45-degree field of view, color fundus image, 2352x1568
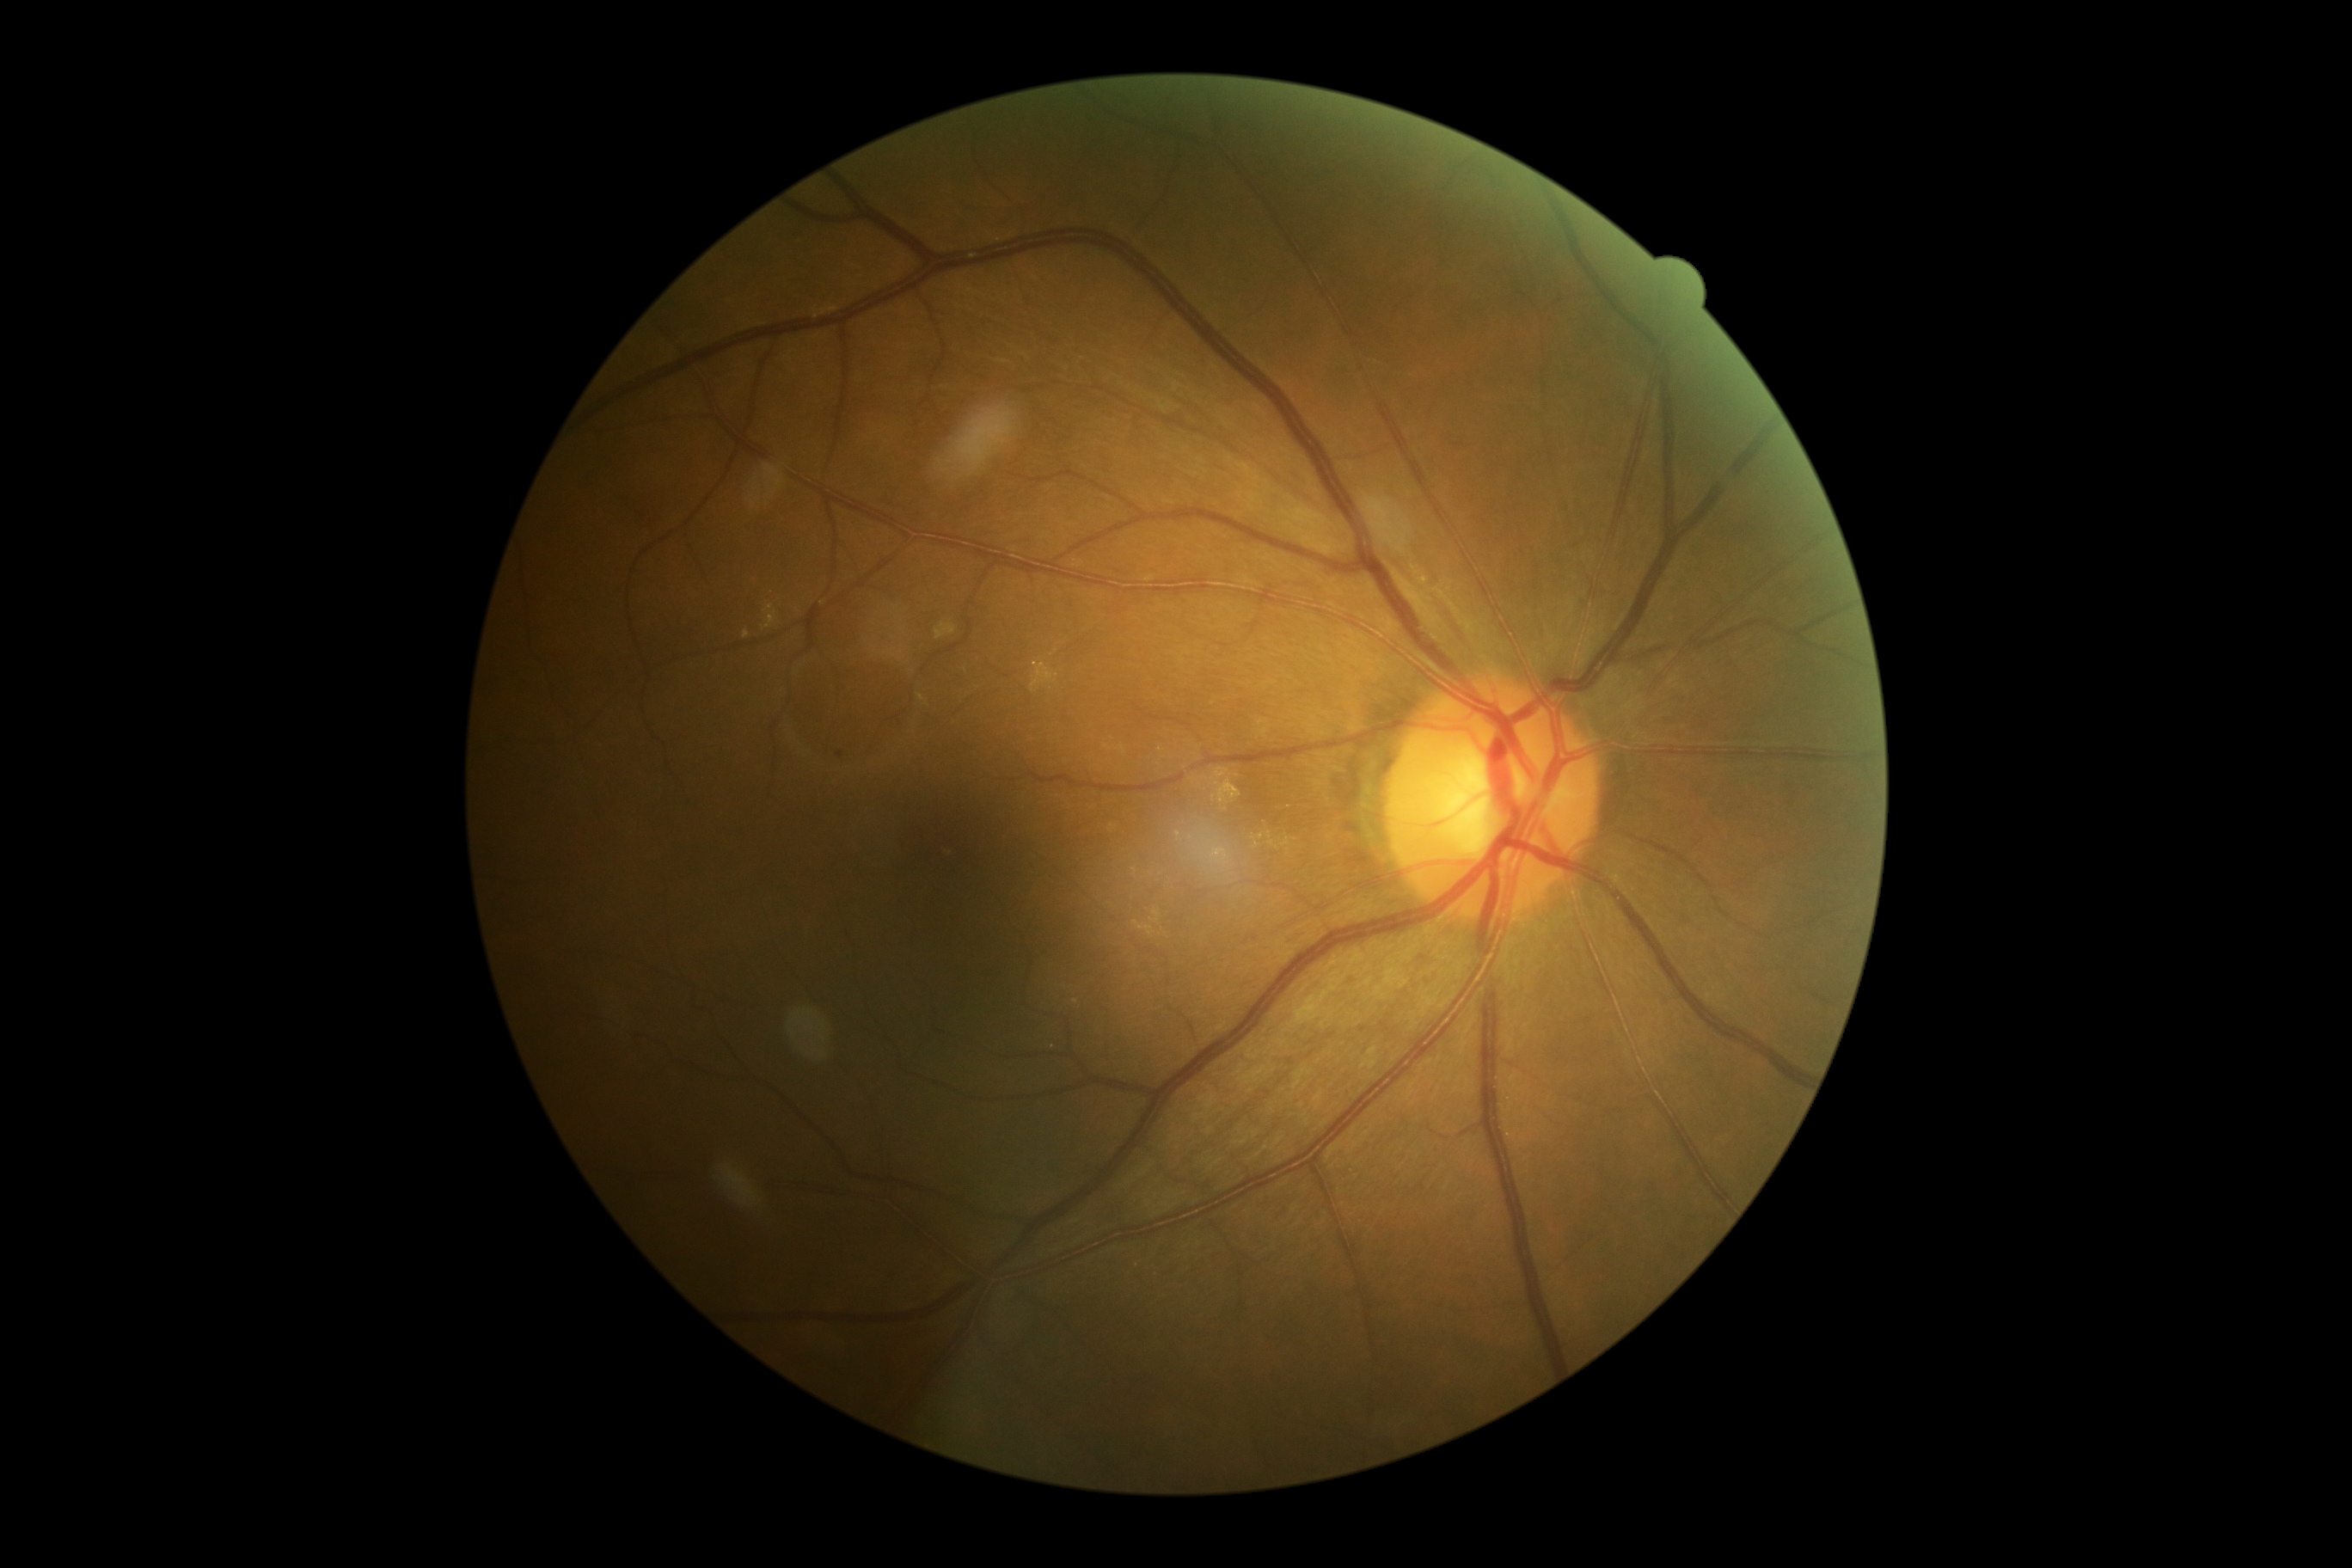 Disease class: non-proliferative diabetic retinopathy.
Retinopathy grade: 2 (moderate NPDR).